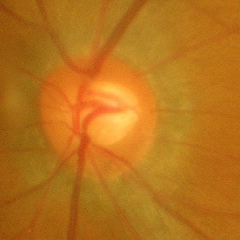

Diagnosis: advanced glaucomatous optic neuropathy.